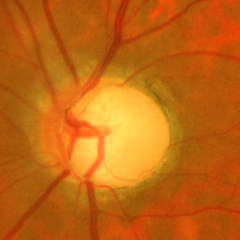
Glaucoma stage = advanced glaucoma.